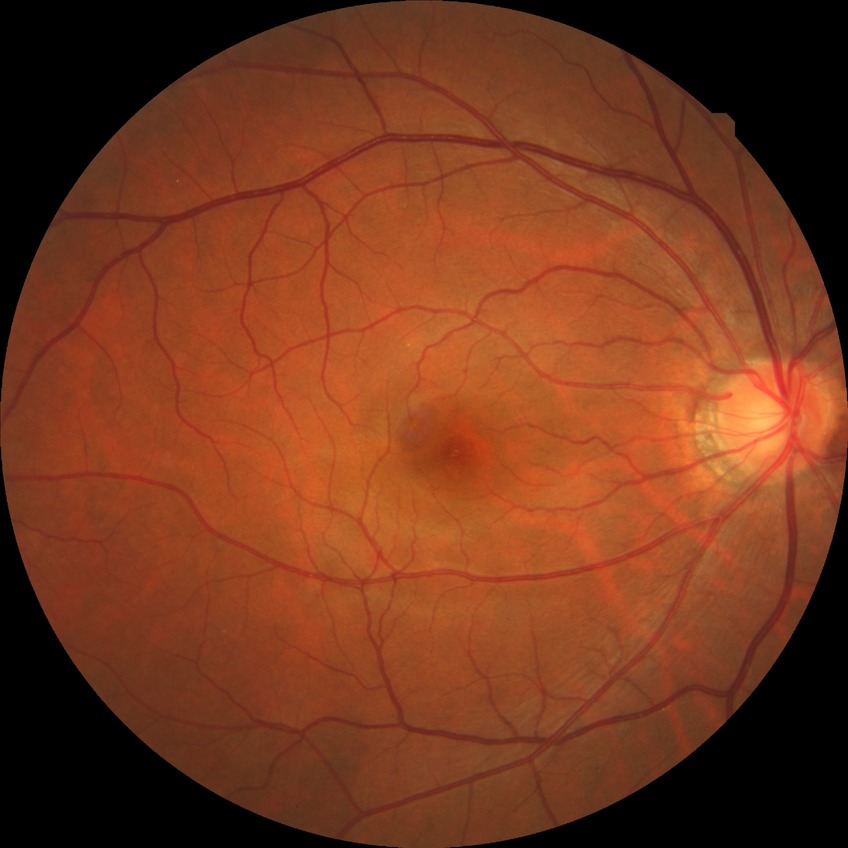

Diabetic retinopathy grade: no diabetic retinopathy.